Posterior pole photograph: 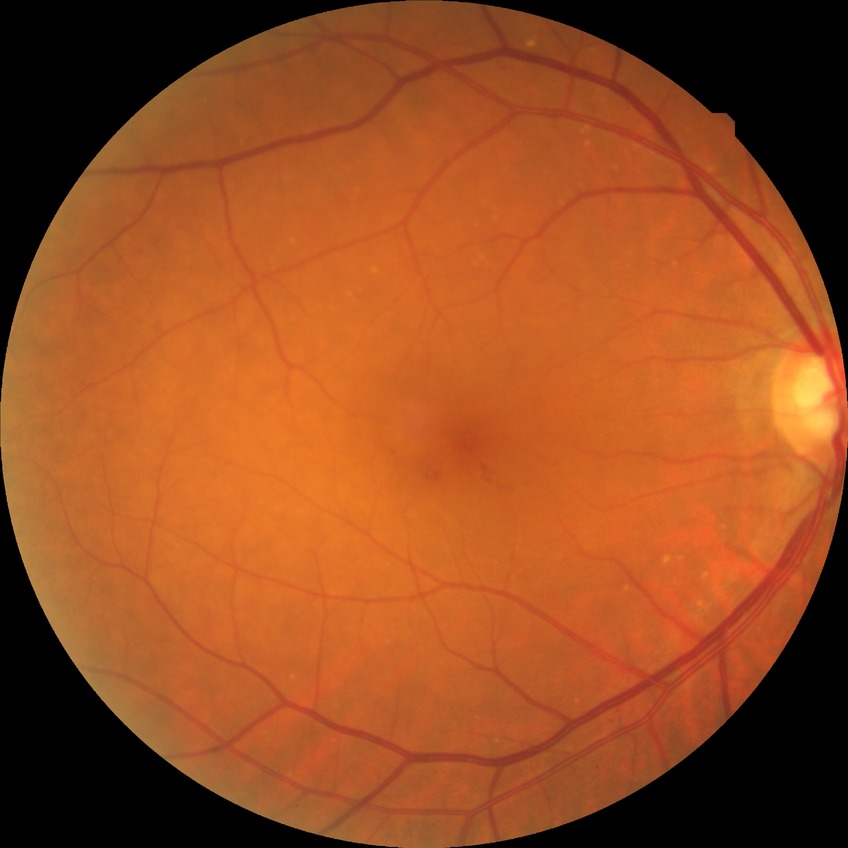
DR class = non-proliferative diabetic retinopathy
DR severity = SDR